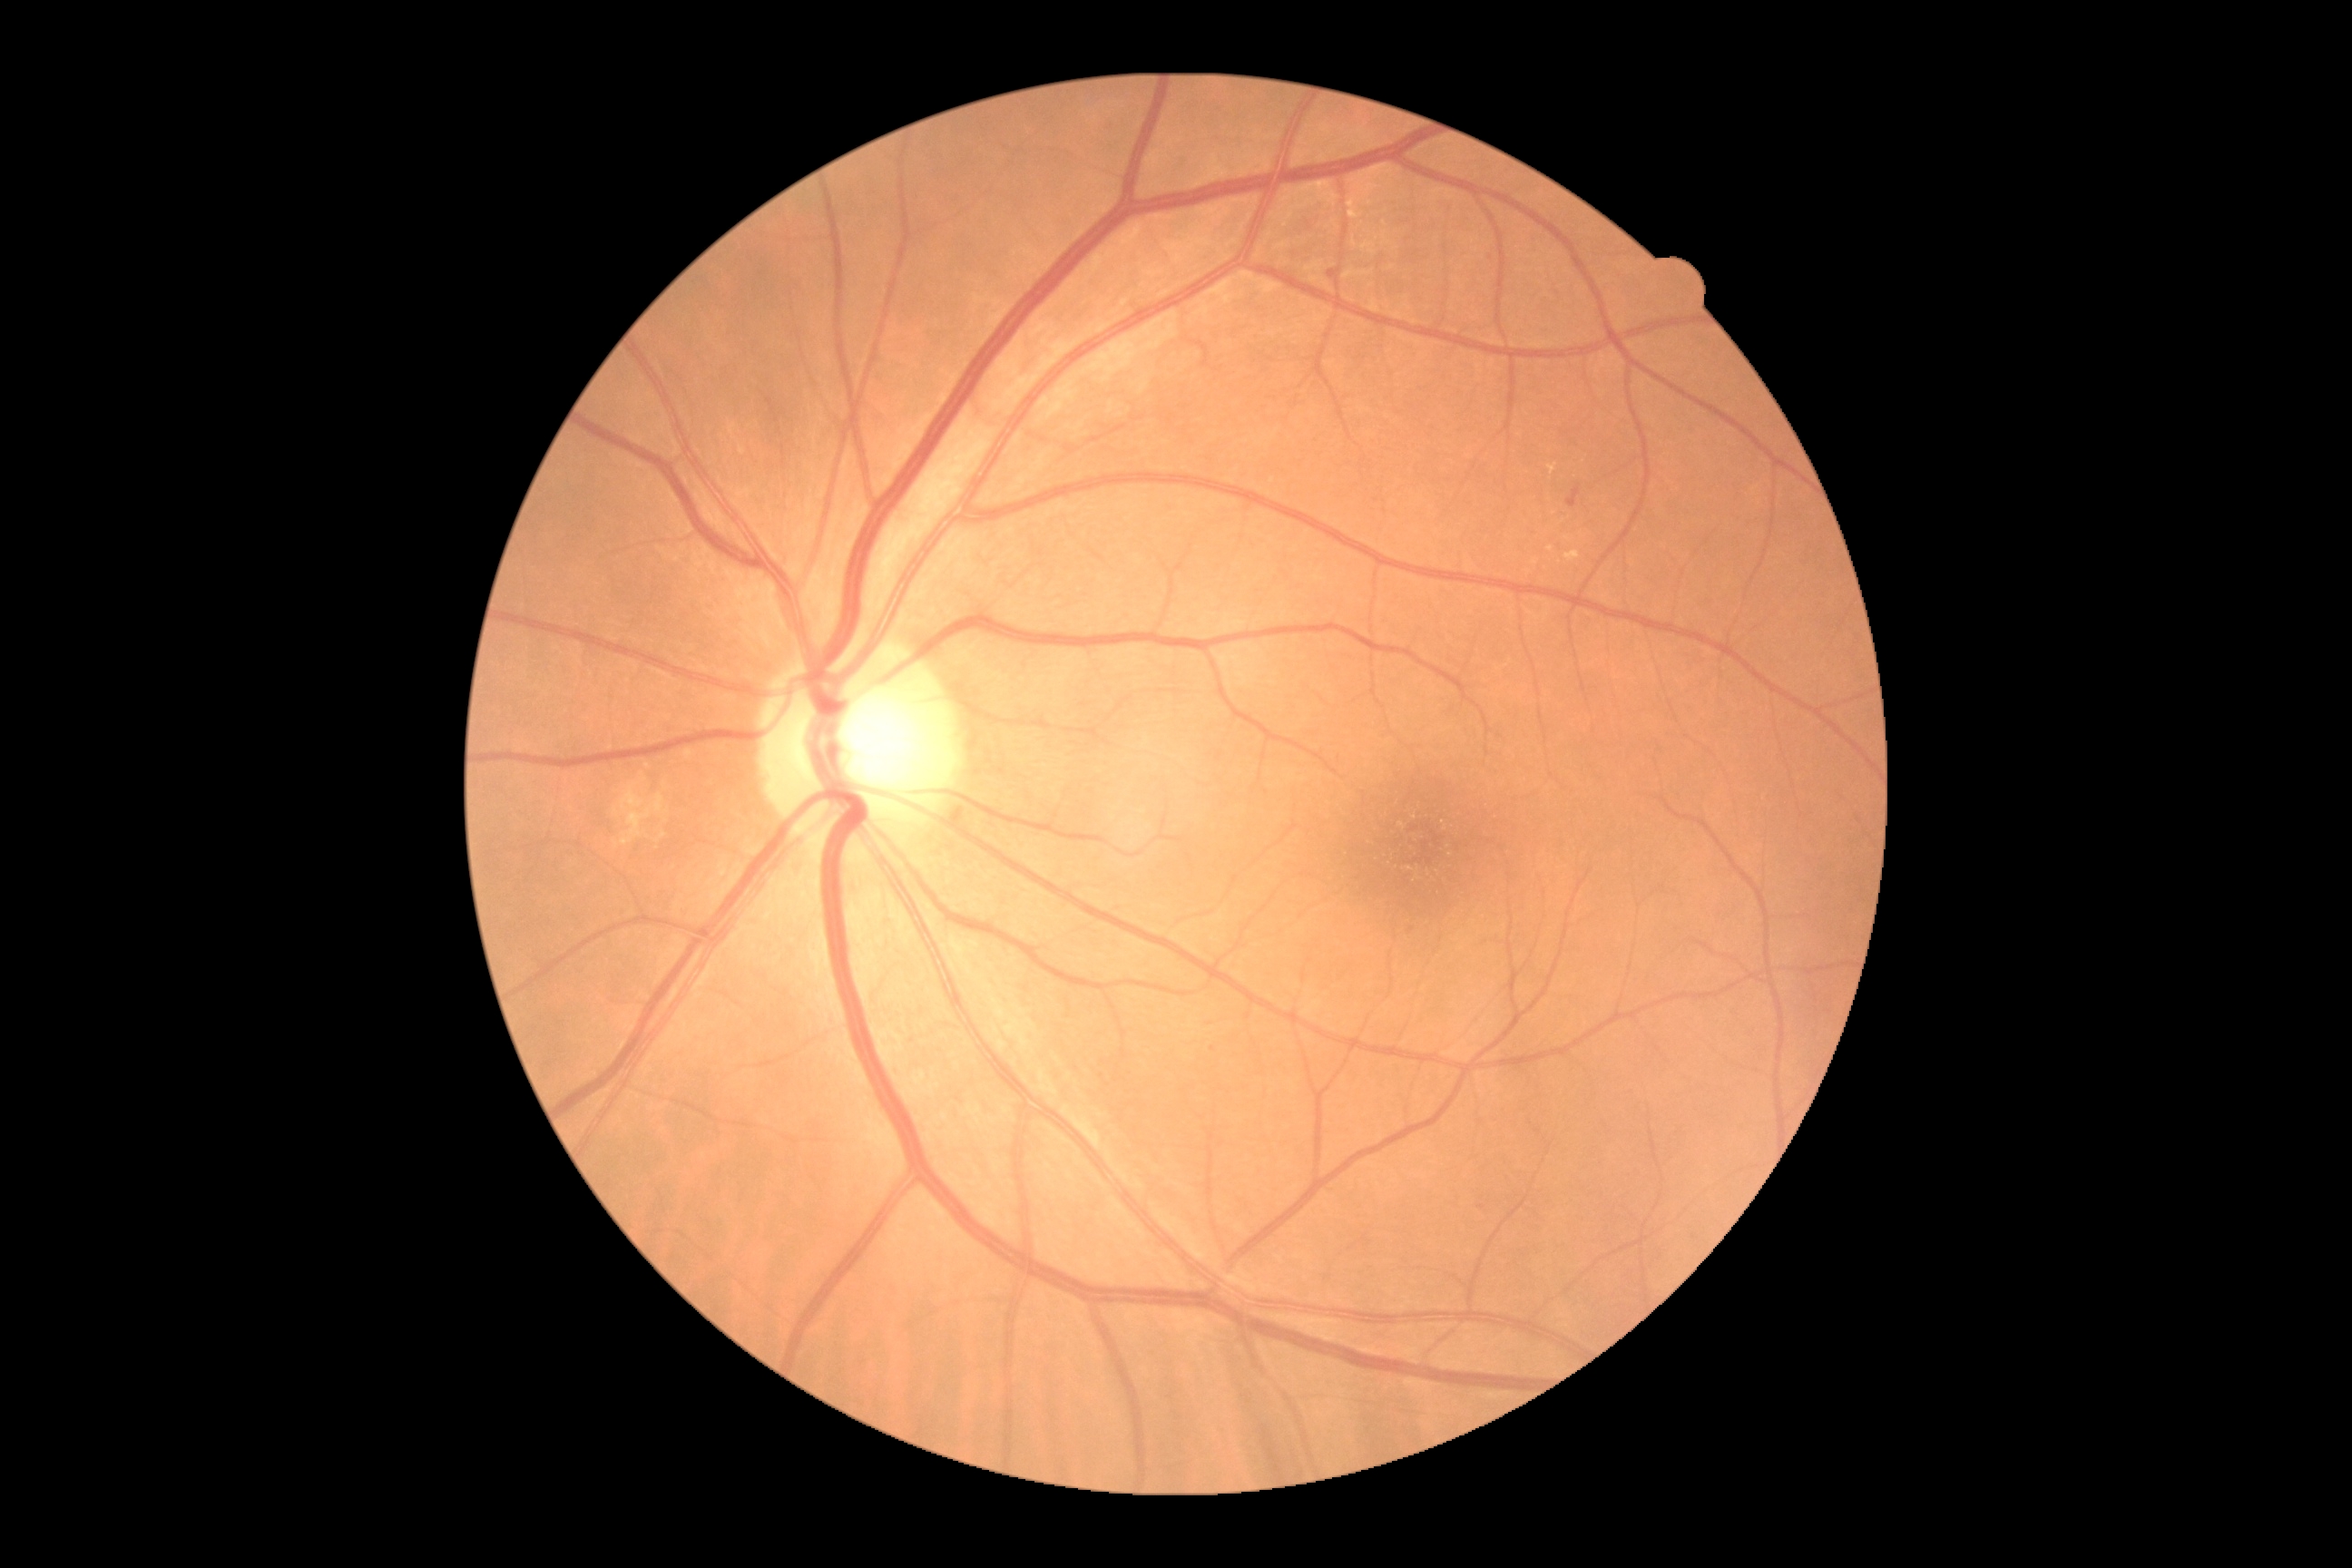
Diabetic retinopathy is grade 2 (moderate NPDR).